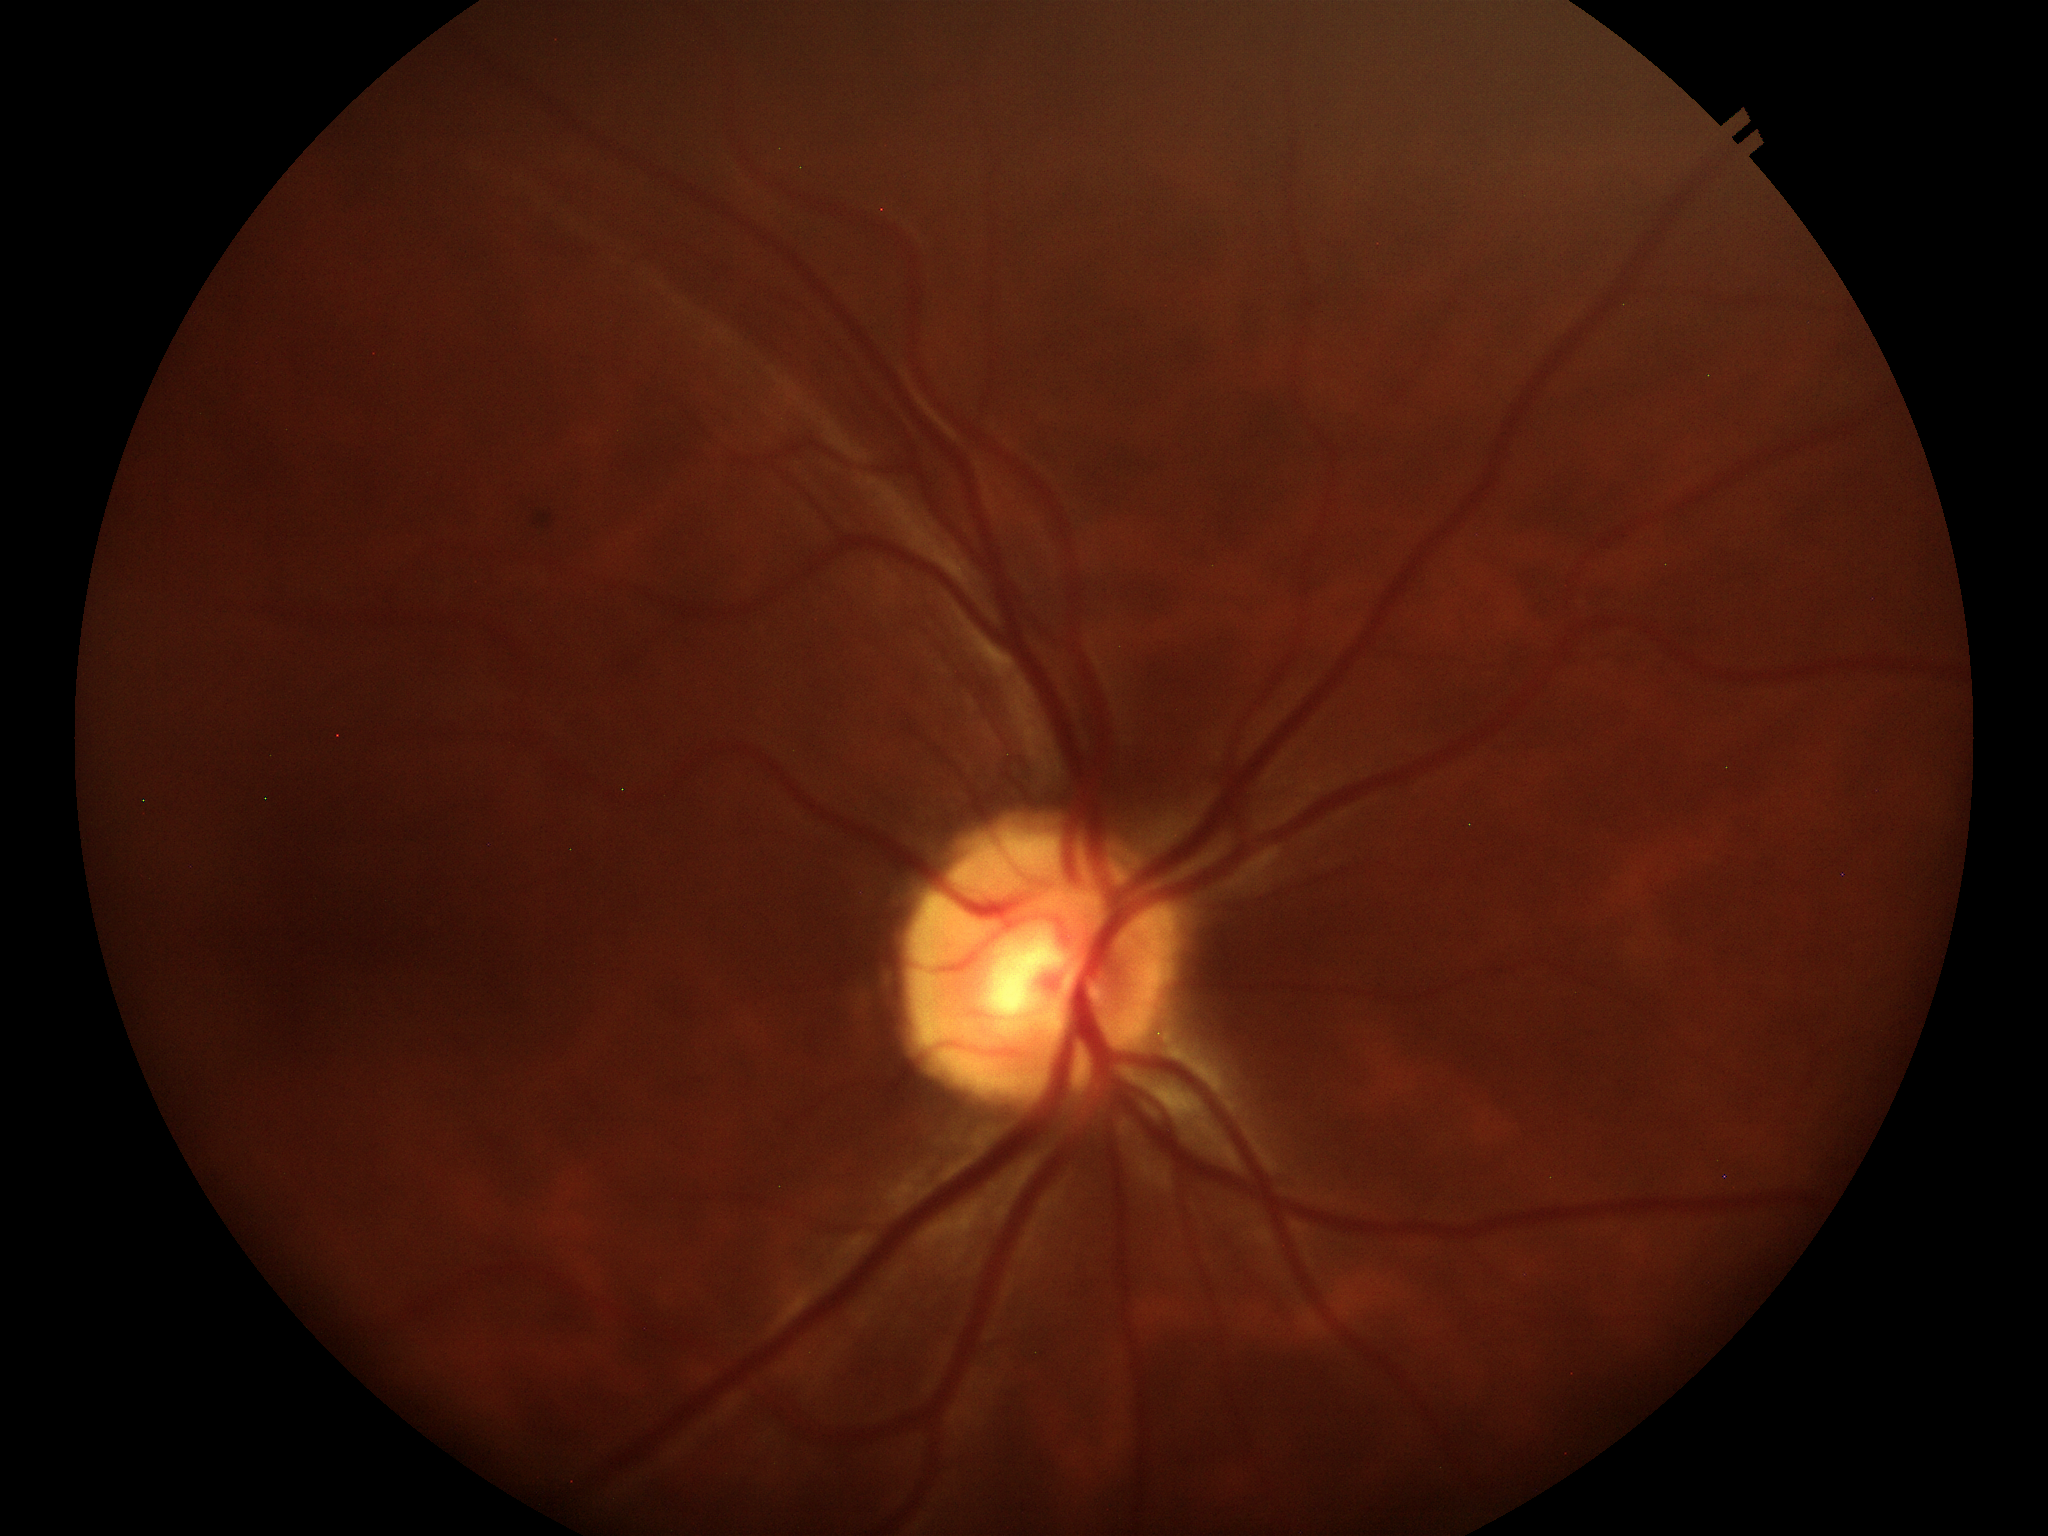

{
  "glaucoma_decision": "not suspect (one of five ophthalmologists flagged glaucoma suspect)",
  "vcdr": "0.46",
  "hcdr": "0.47"
}